Non-mydriatic fundus camera. Fundus photo:
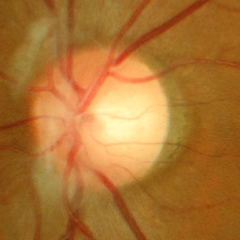

Diagnosis: early glaucomatous changes. Defined as glaucomatous retinal nerve fiber layer defects on red-free fundus photography without visual field defects.